2352 by 1568 pixels · retinal fundus photograph · 45-degree field of view — 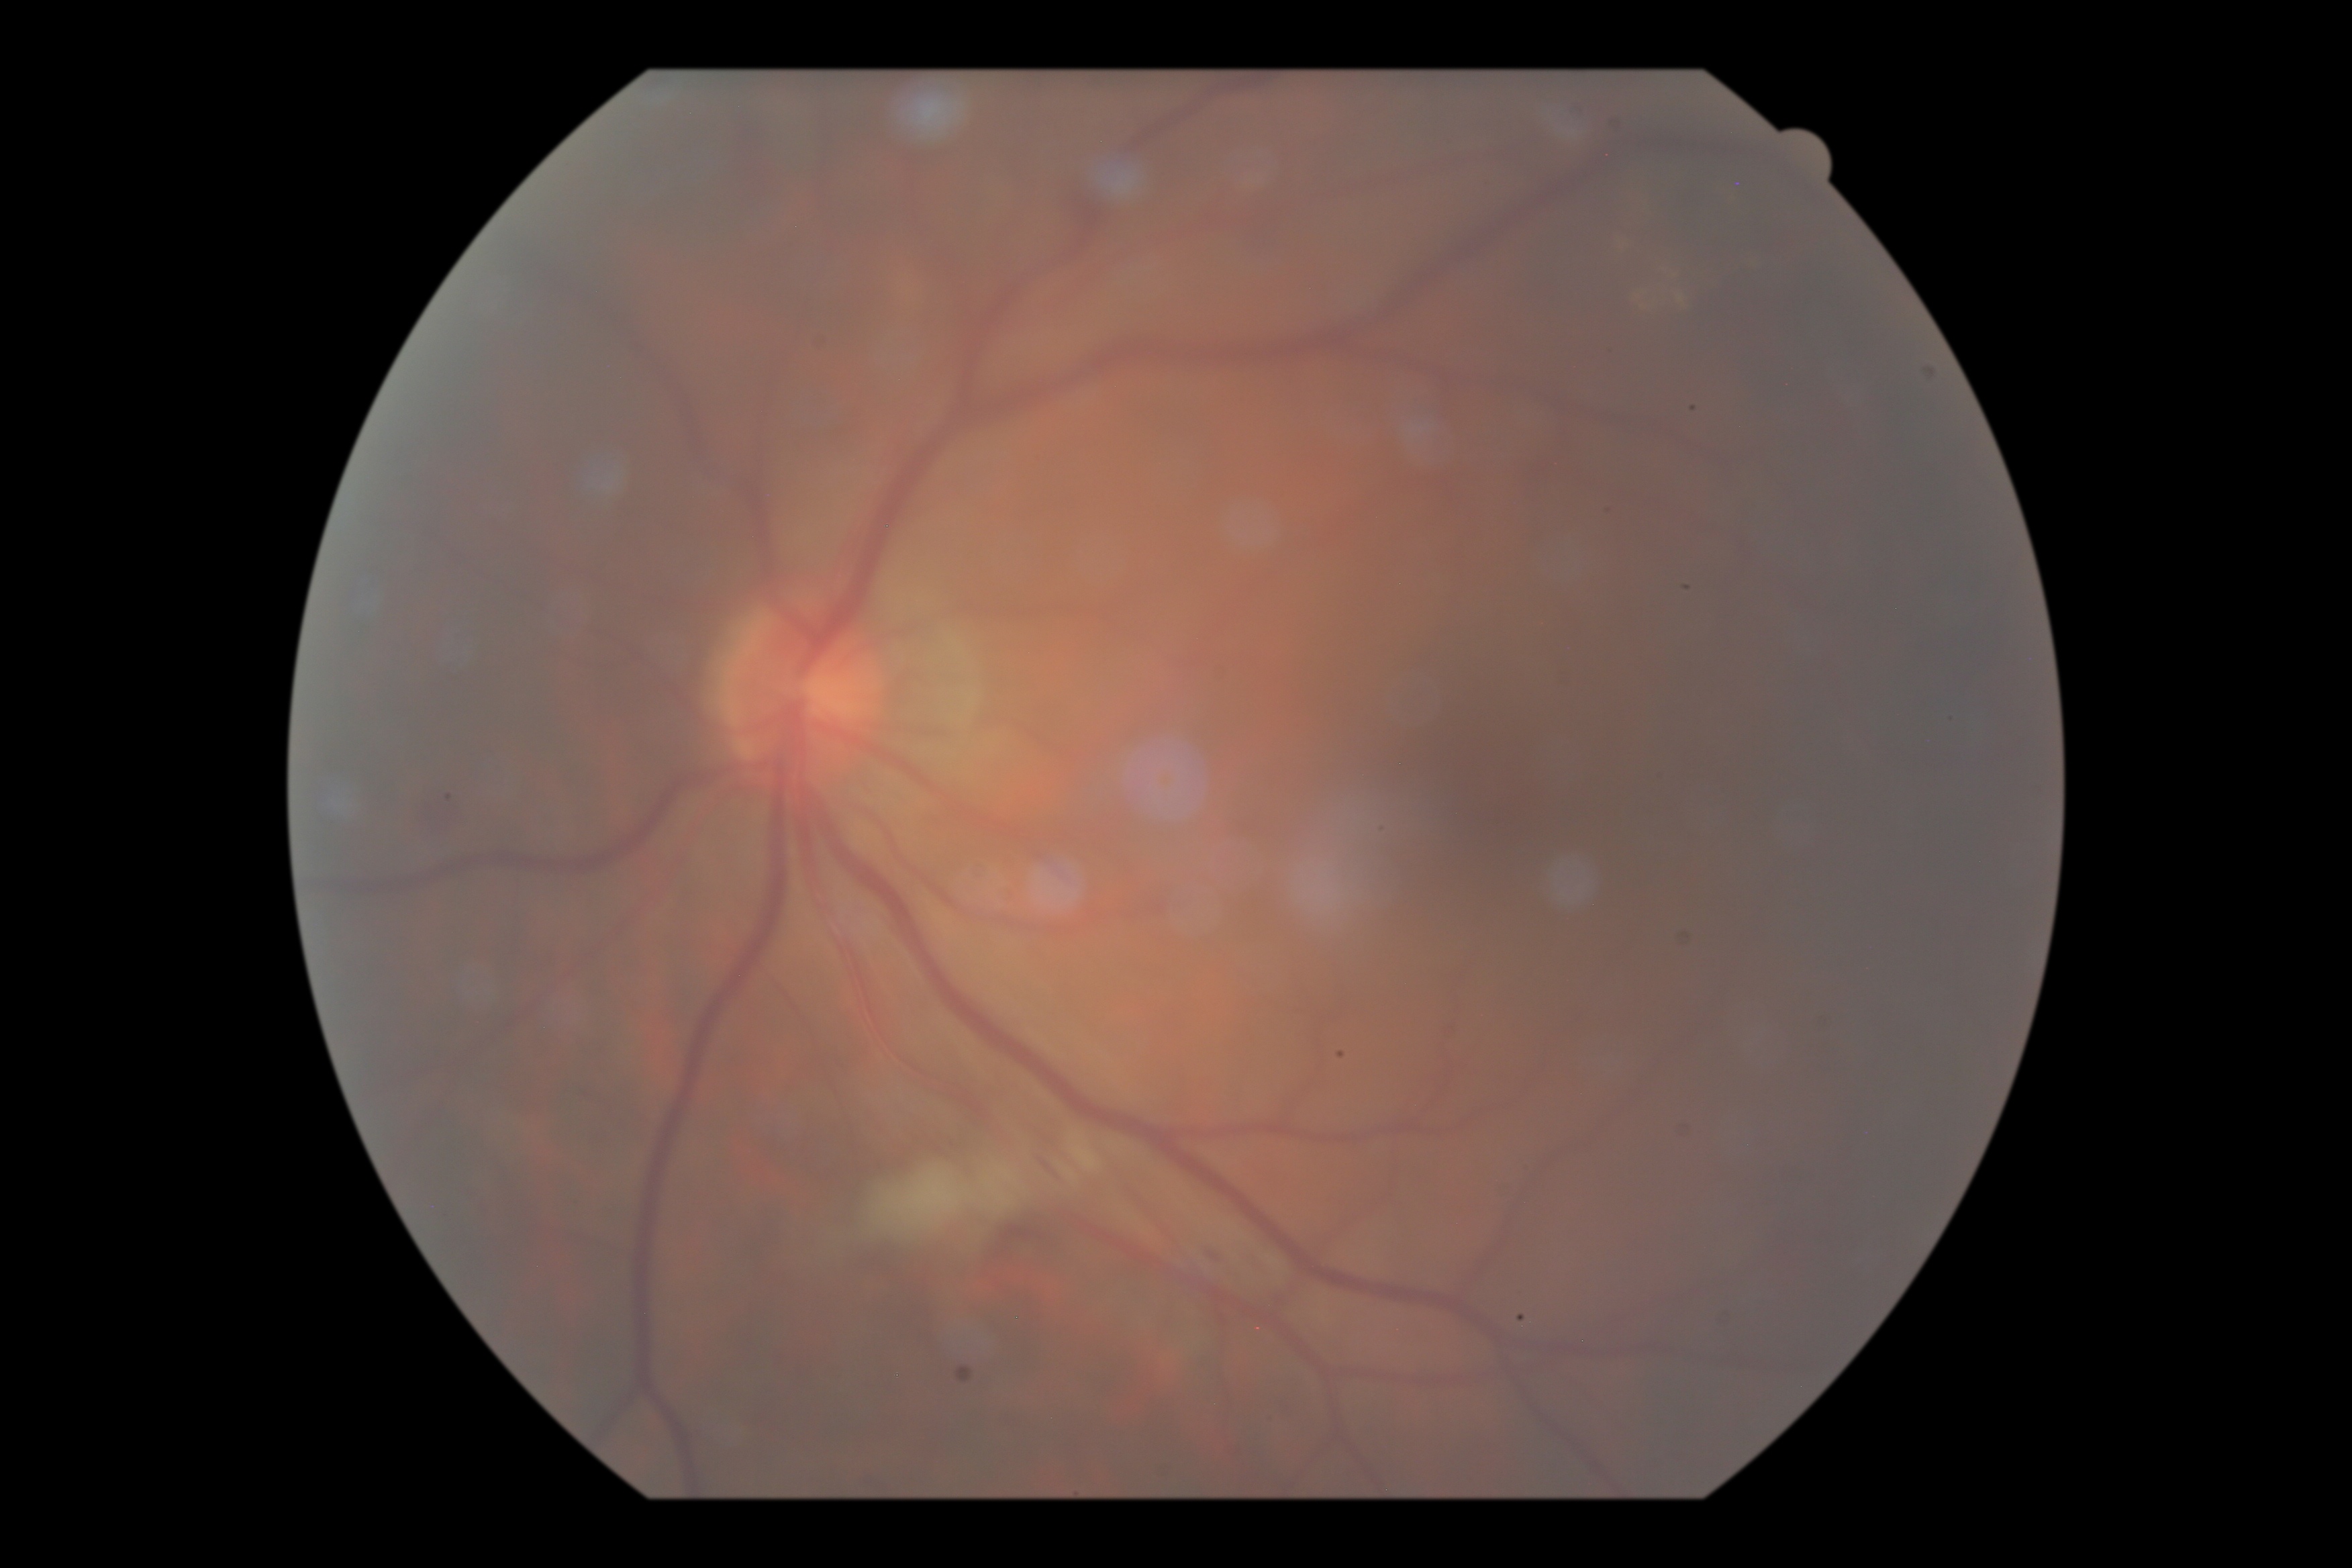

Diabetic retinopathy (DR): grade 2 (moderate NPDR).